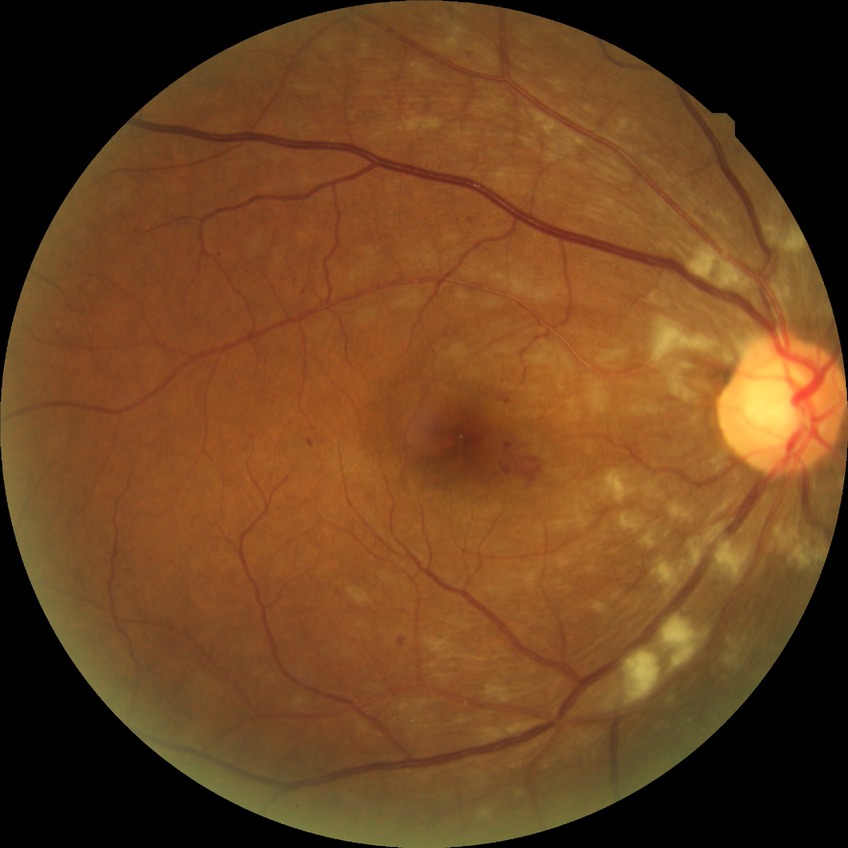

DR grade is PPDR.